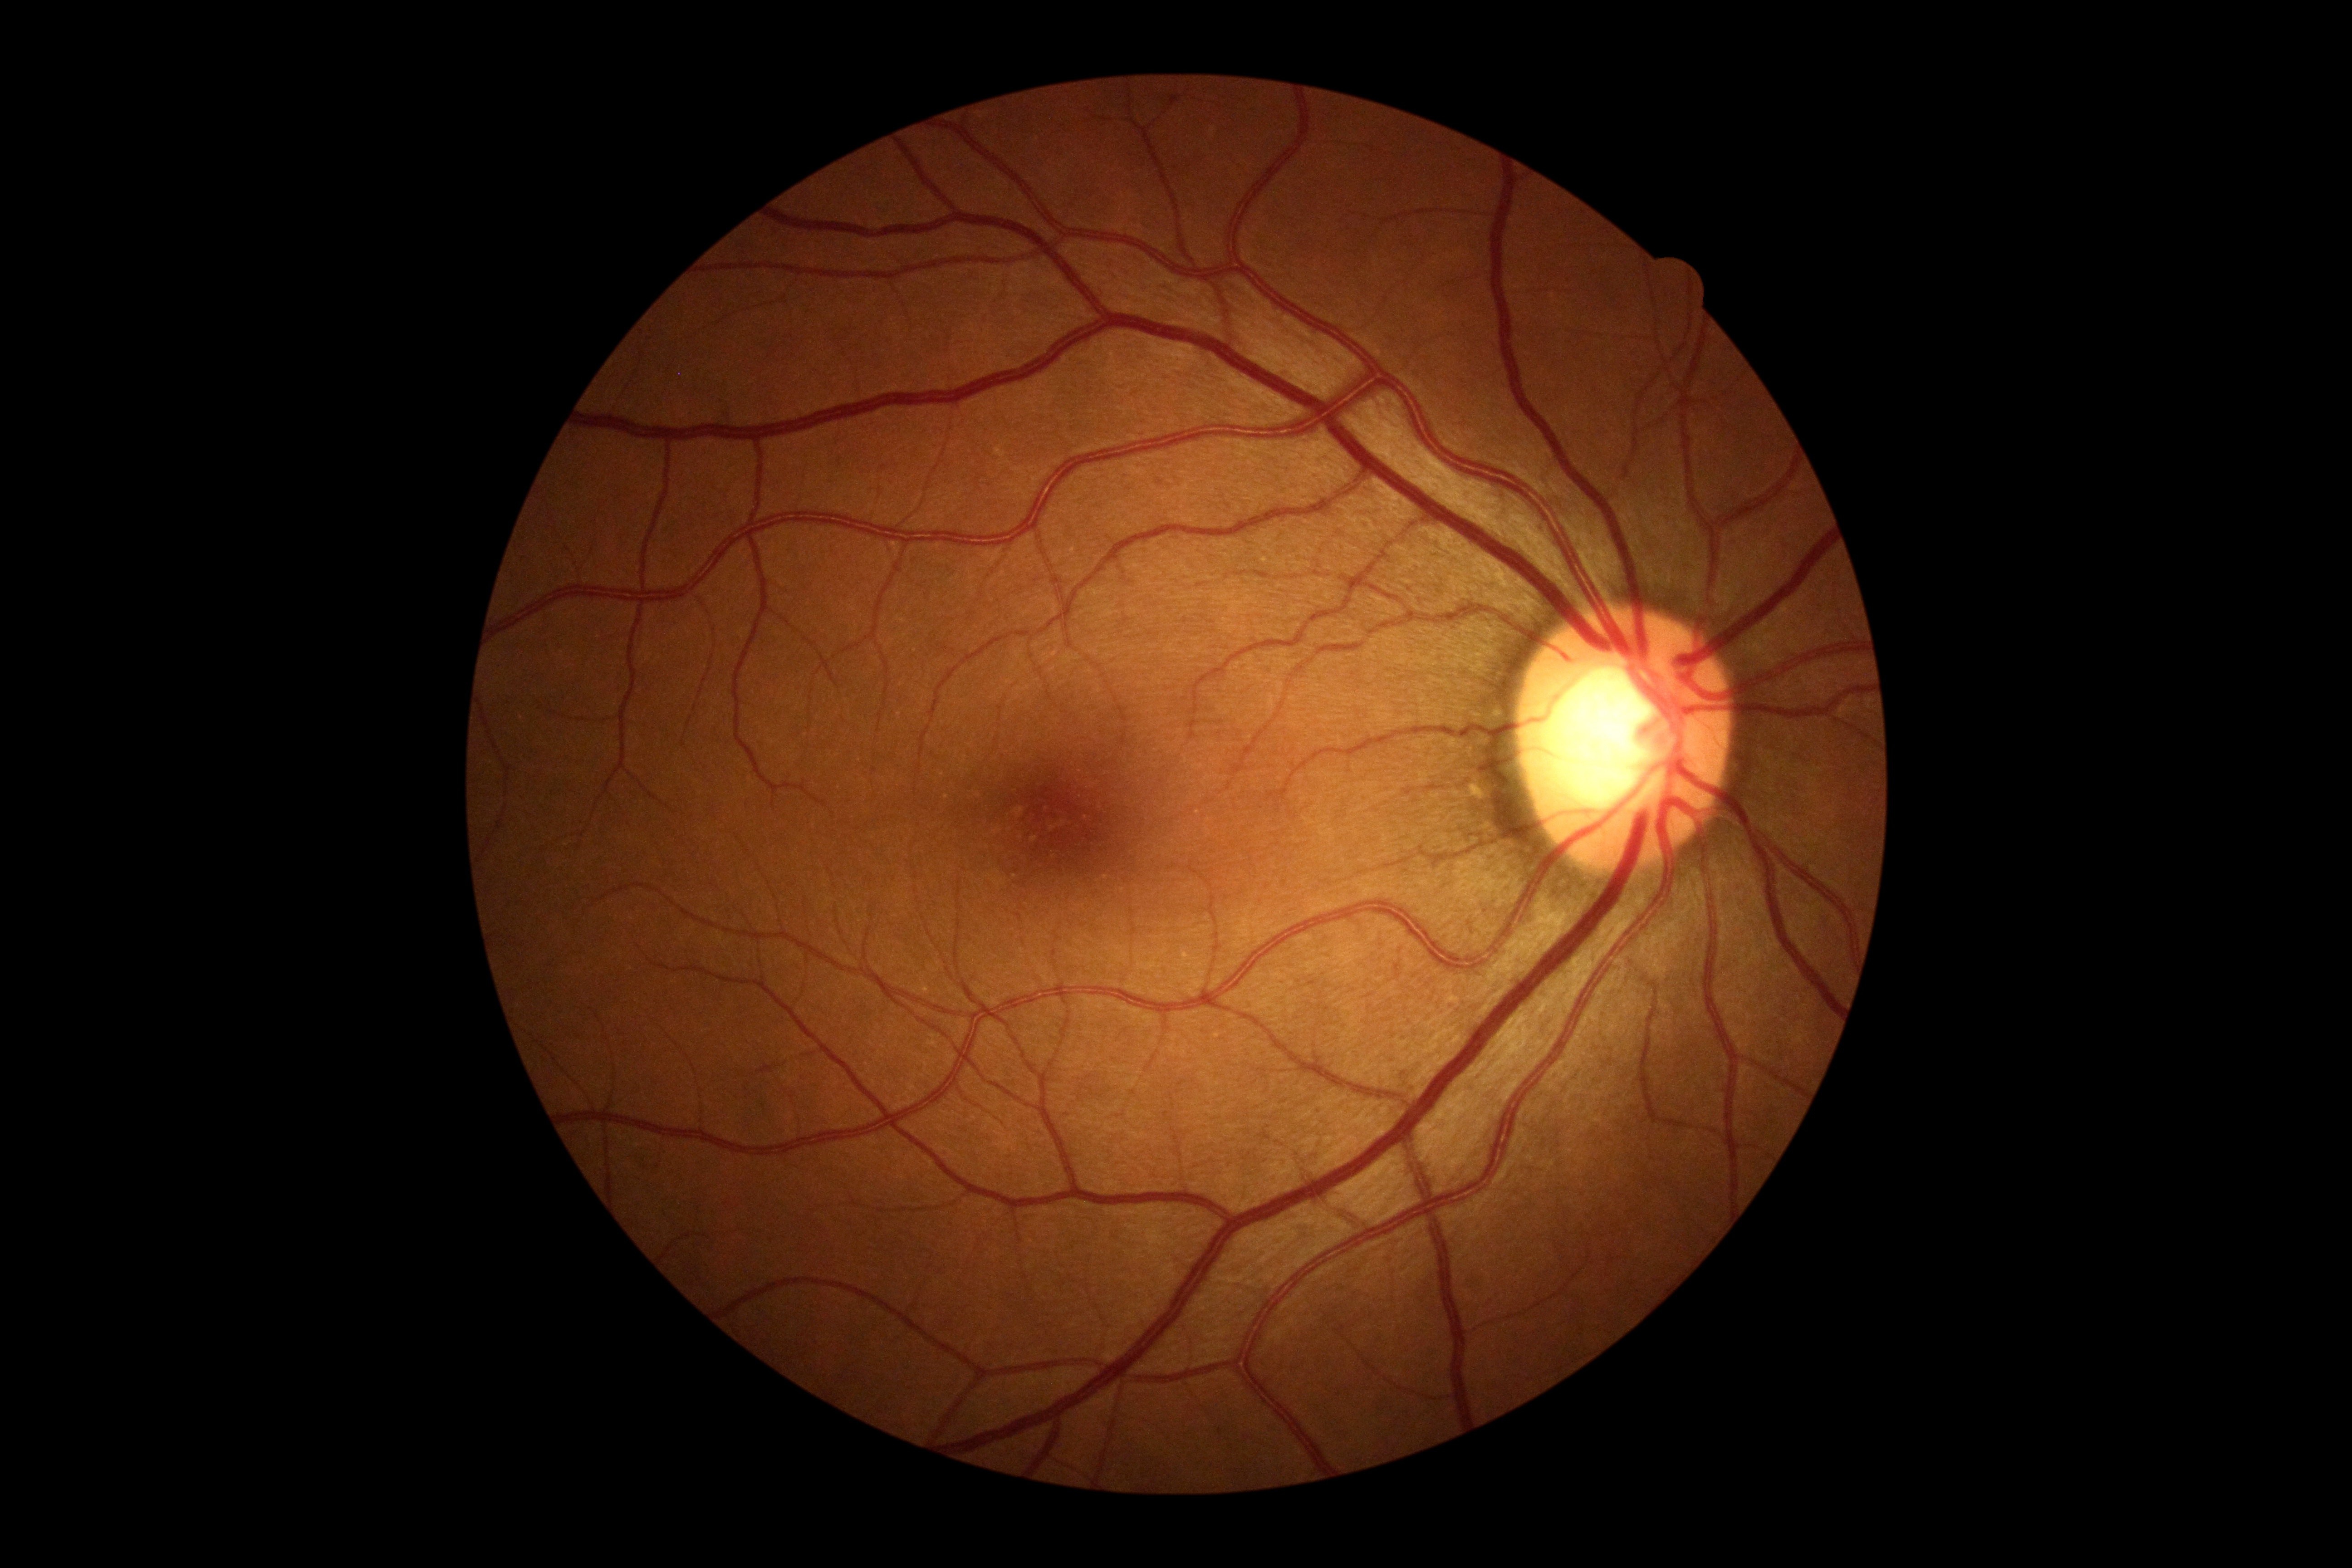

Findings:
- DR severity: no apparent diabetic retinopathy (grade 0)